45° field of view. Color fundus photograph:
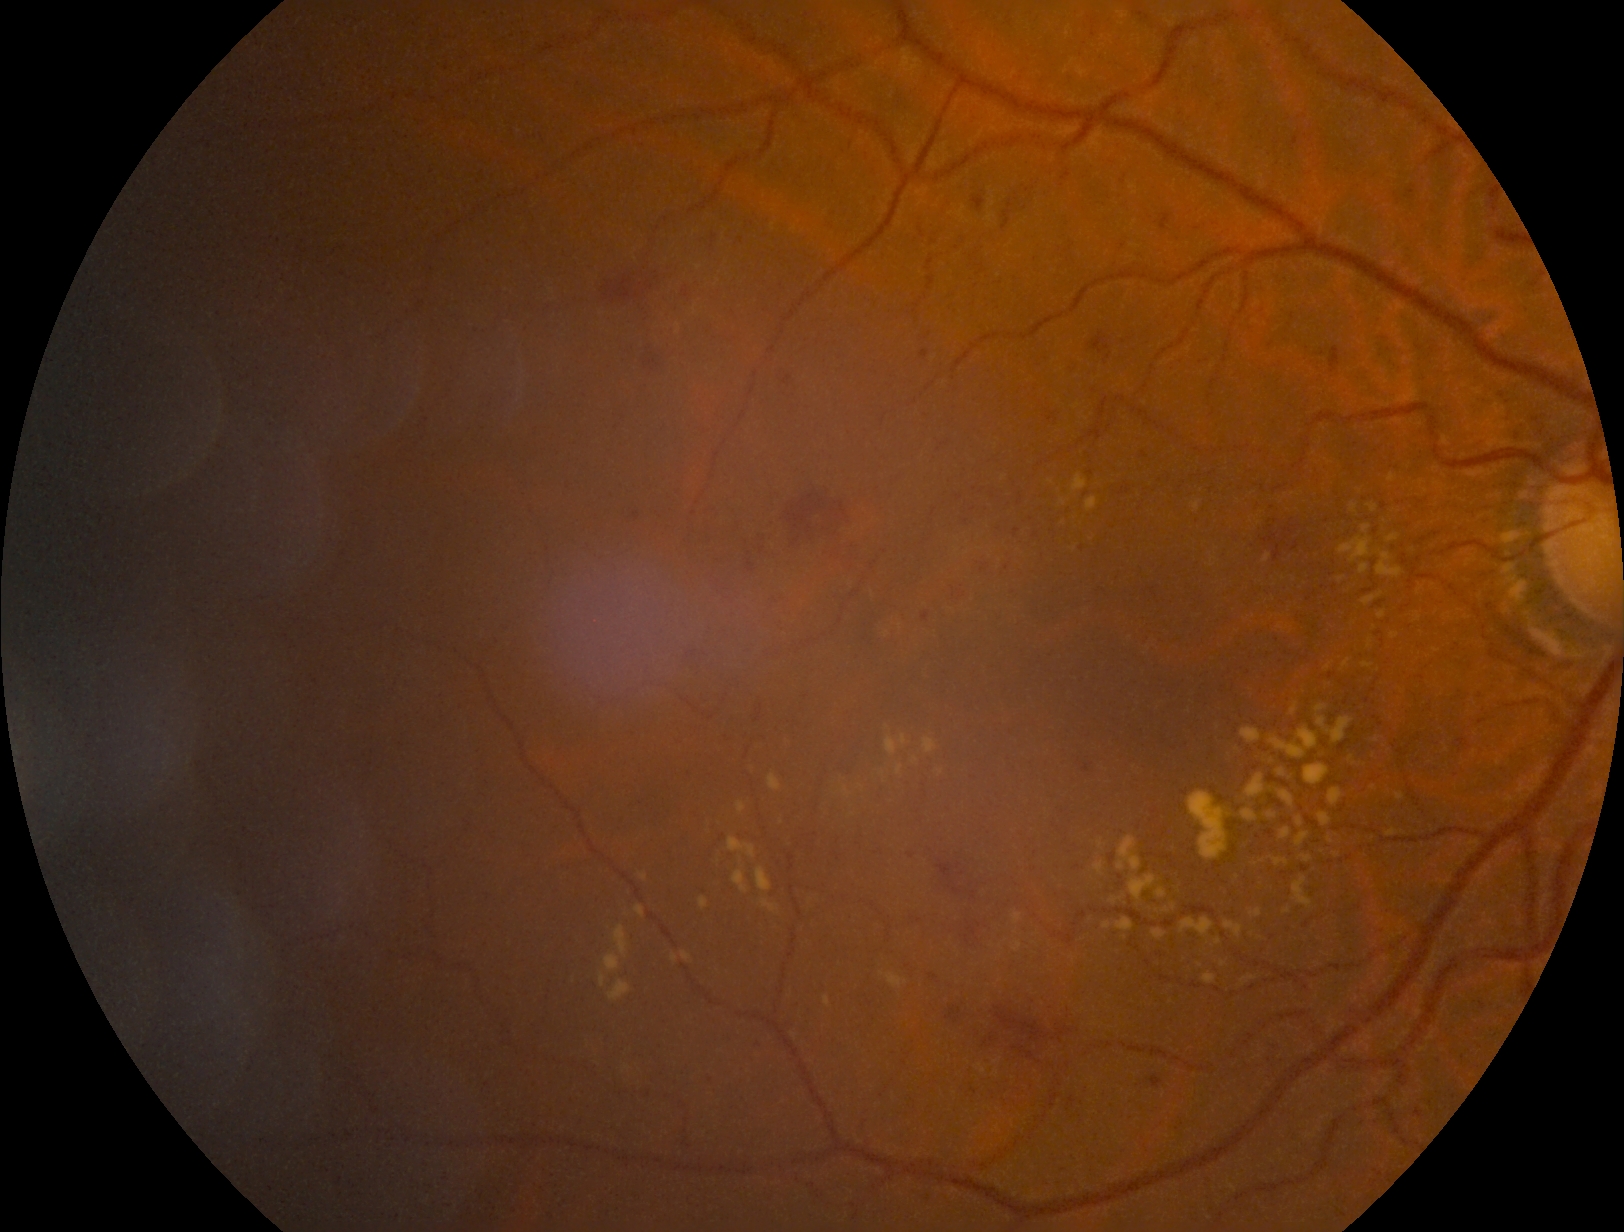

DR grade=2.